45-degree field of view; image size 2048x1536
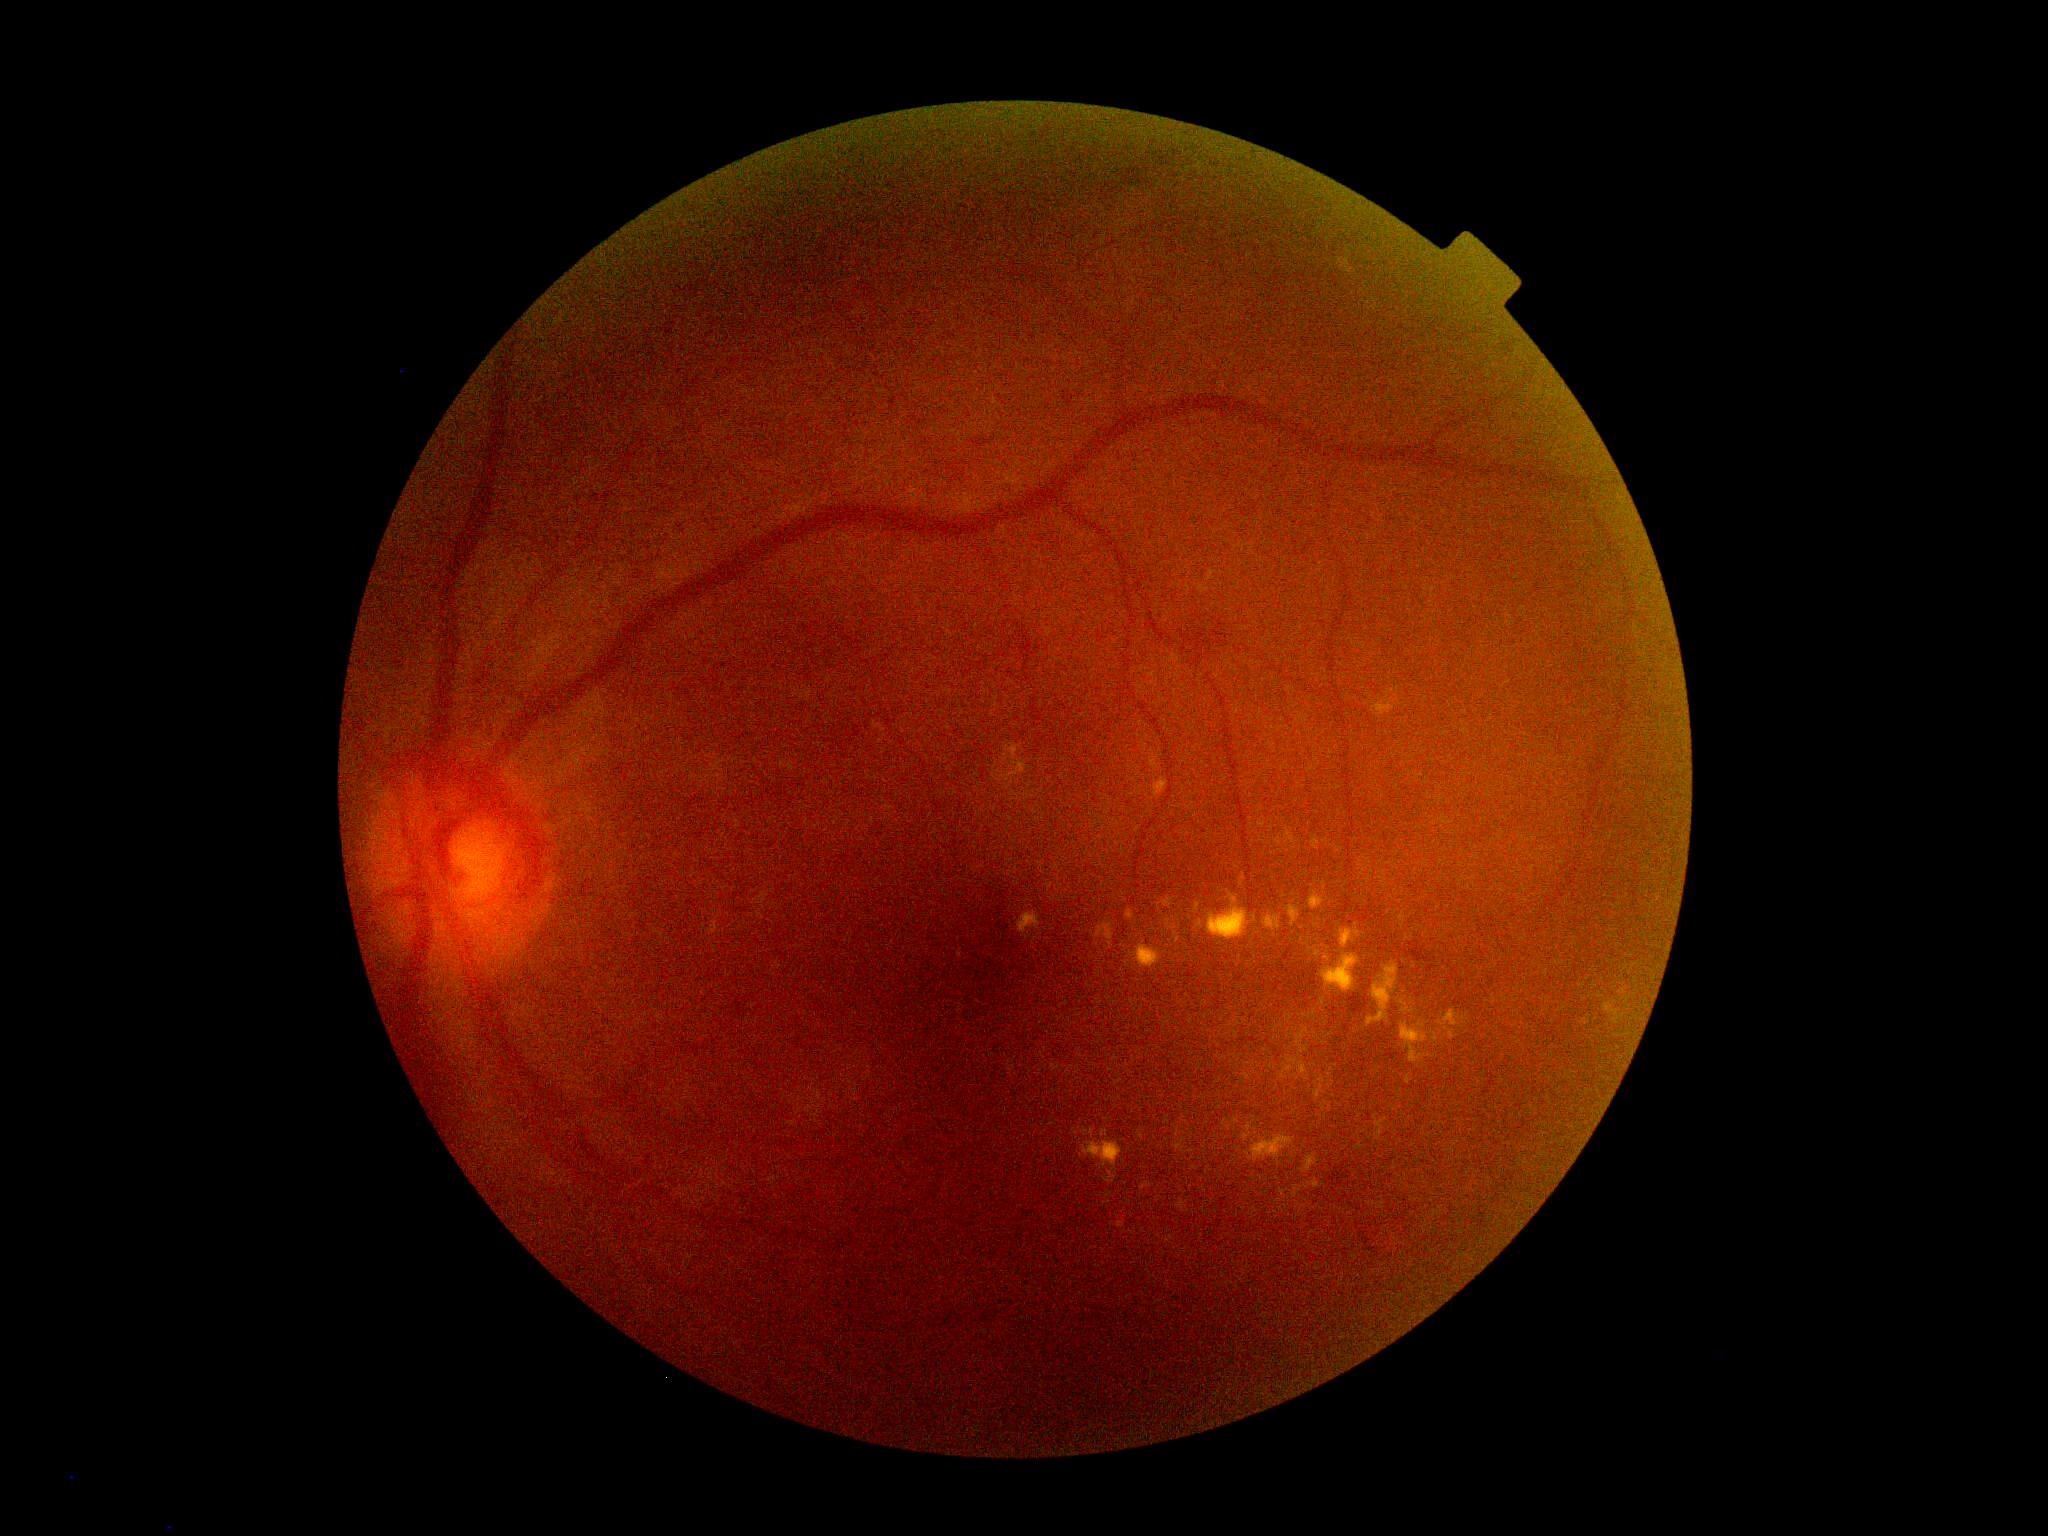 dr_category: non-proliferative diabetic retinopathy
dr_grade: moderate NPDR (grade 2)